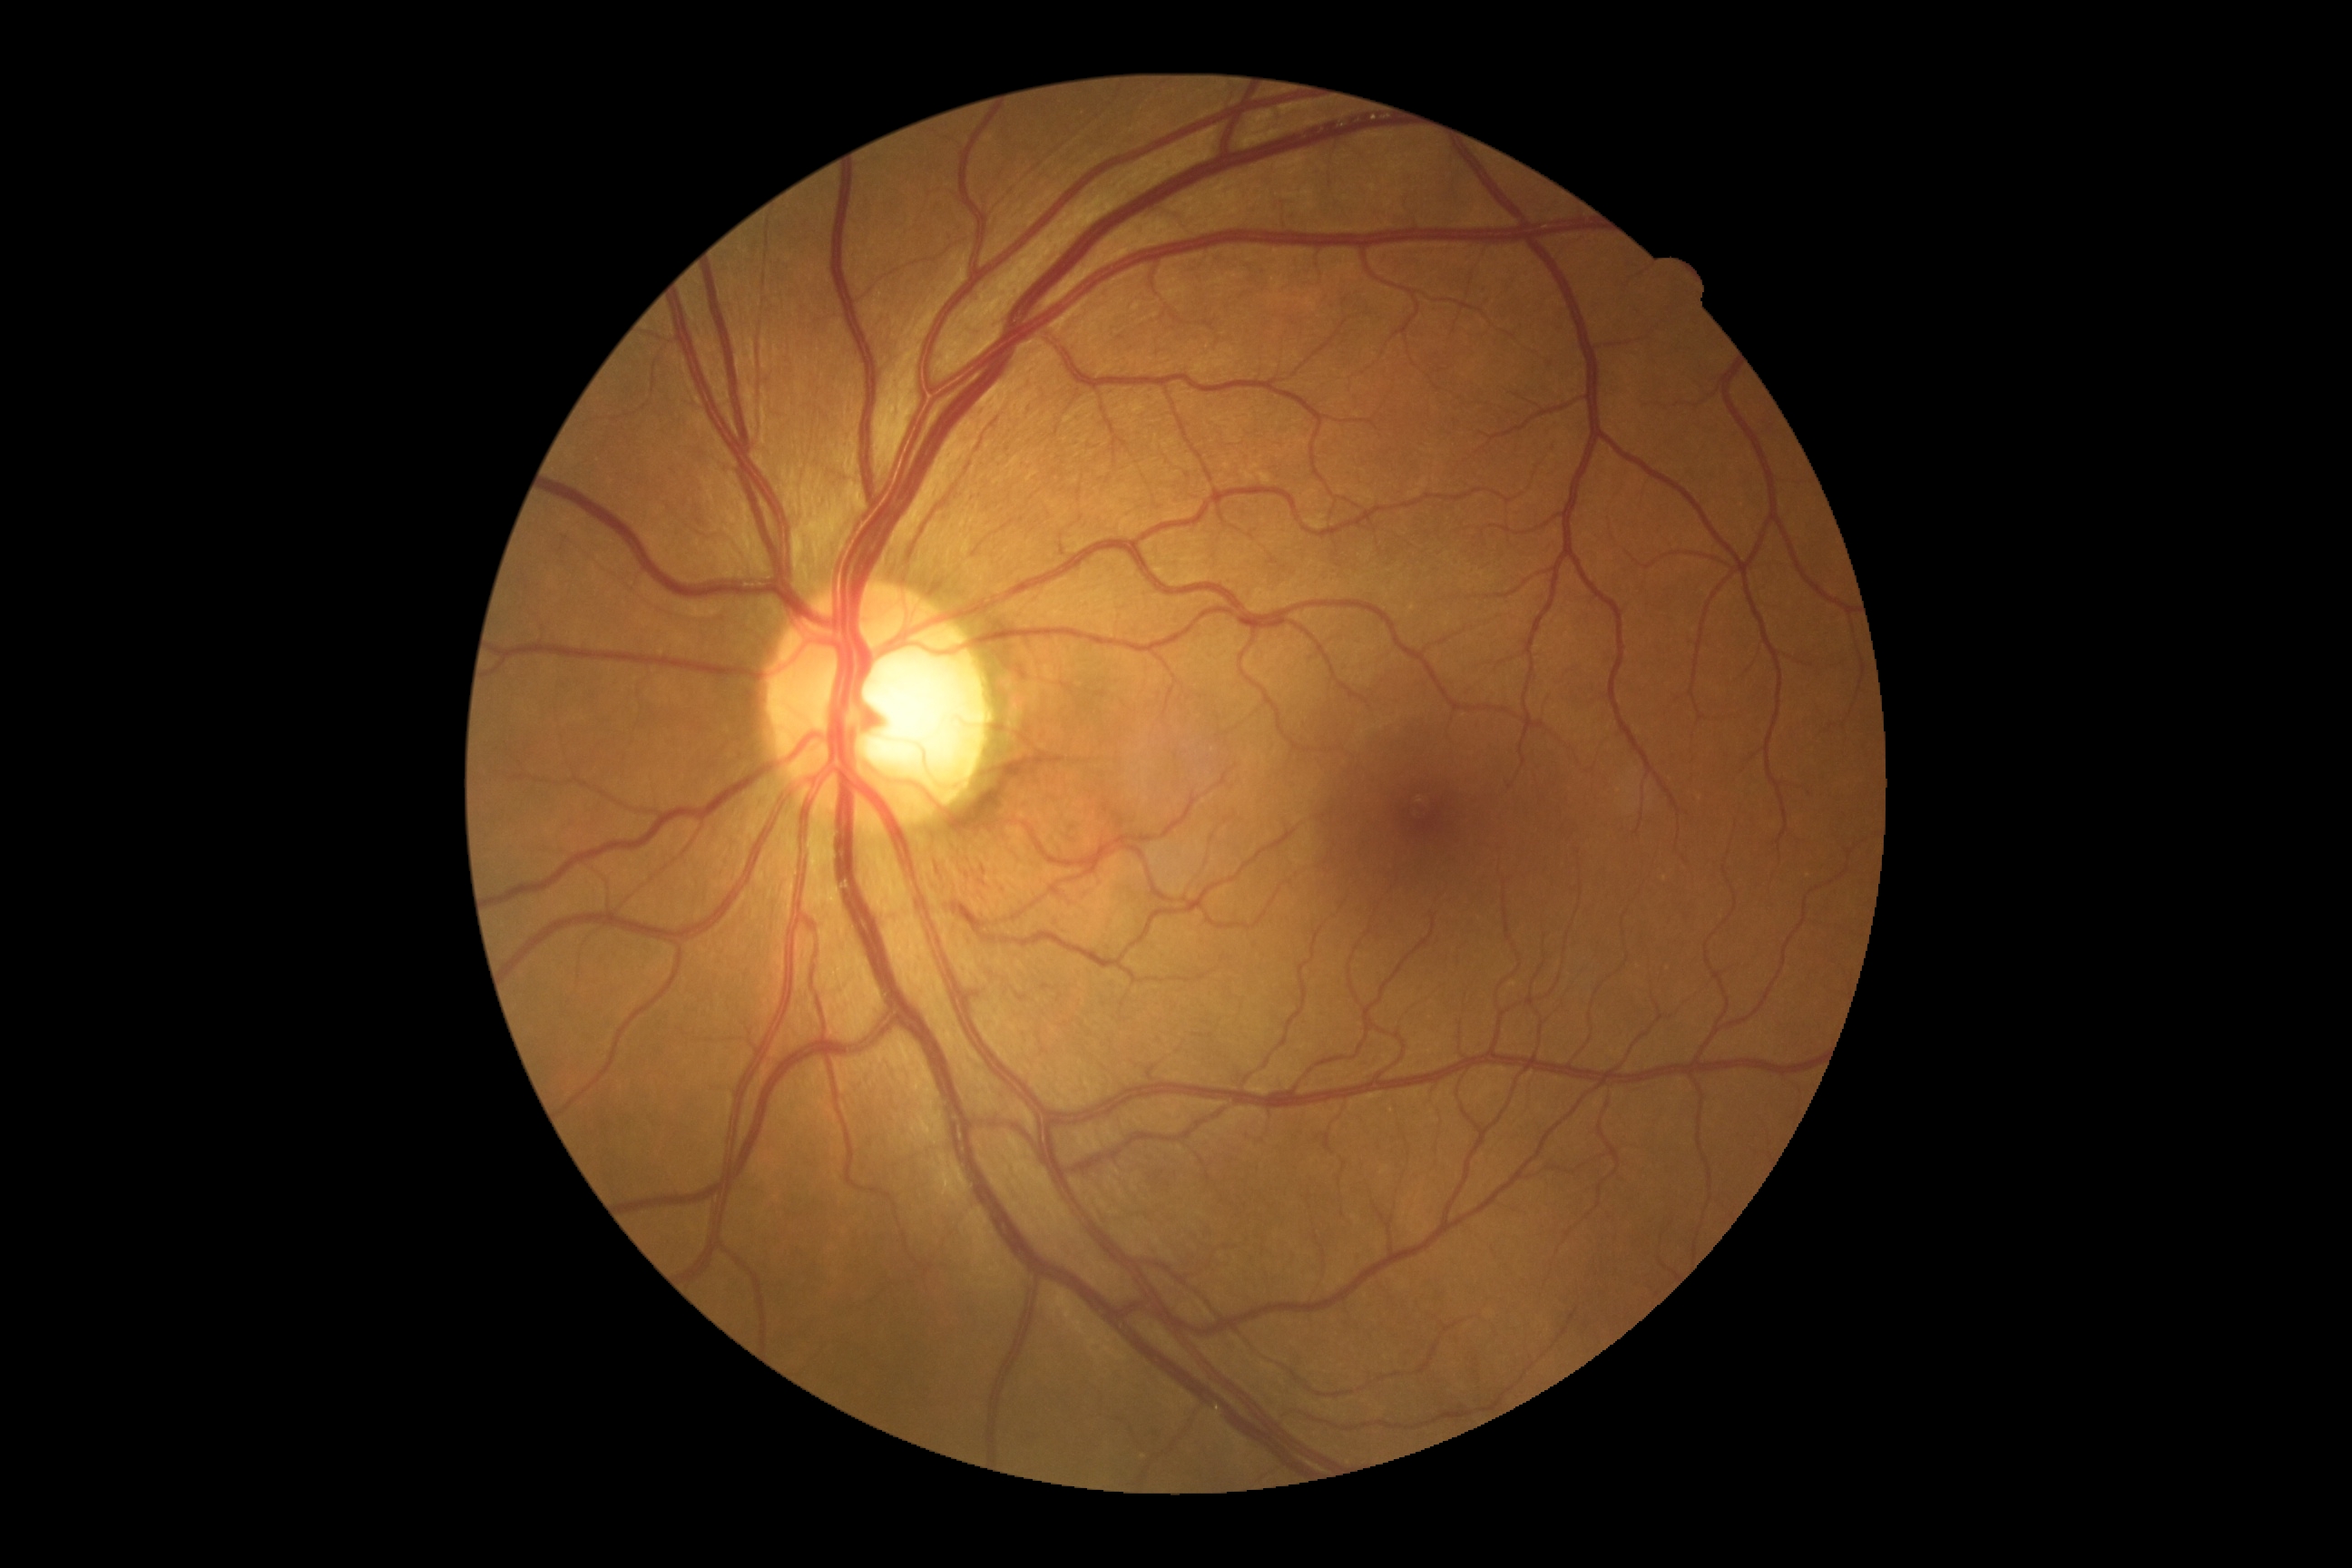
DR grade@moderate non-proliferative diabetic retinopathy (2).